Image size 2212x1659. Color fundus image:
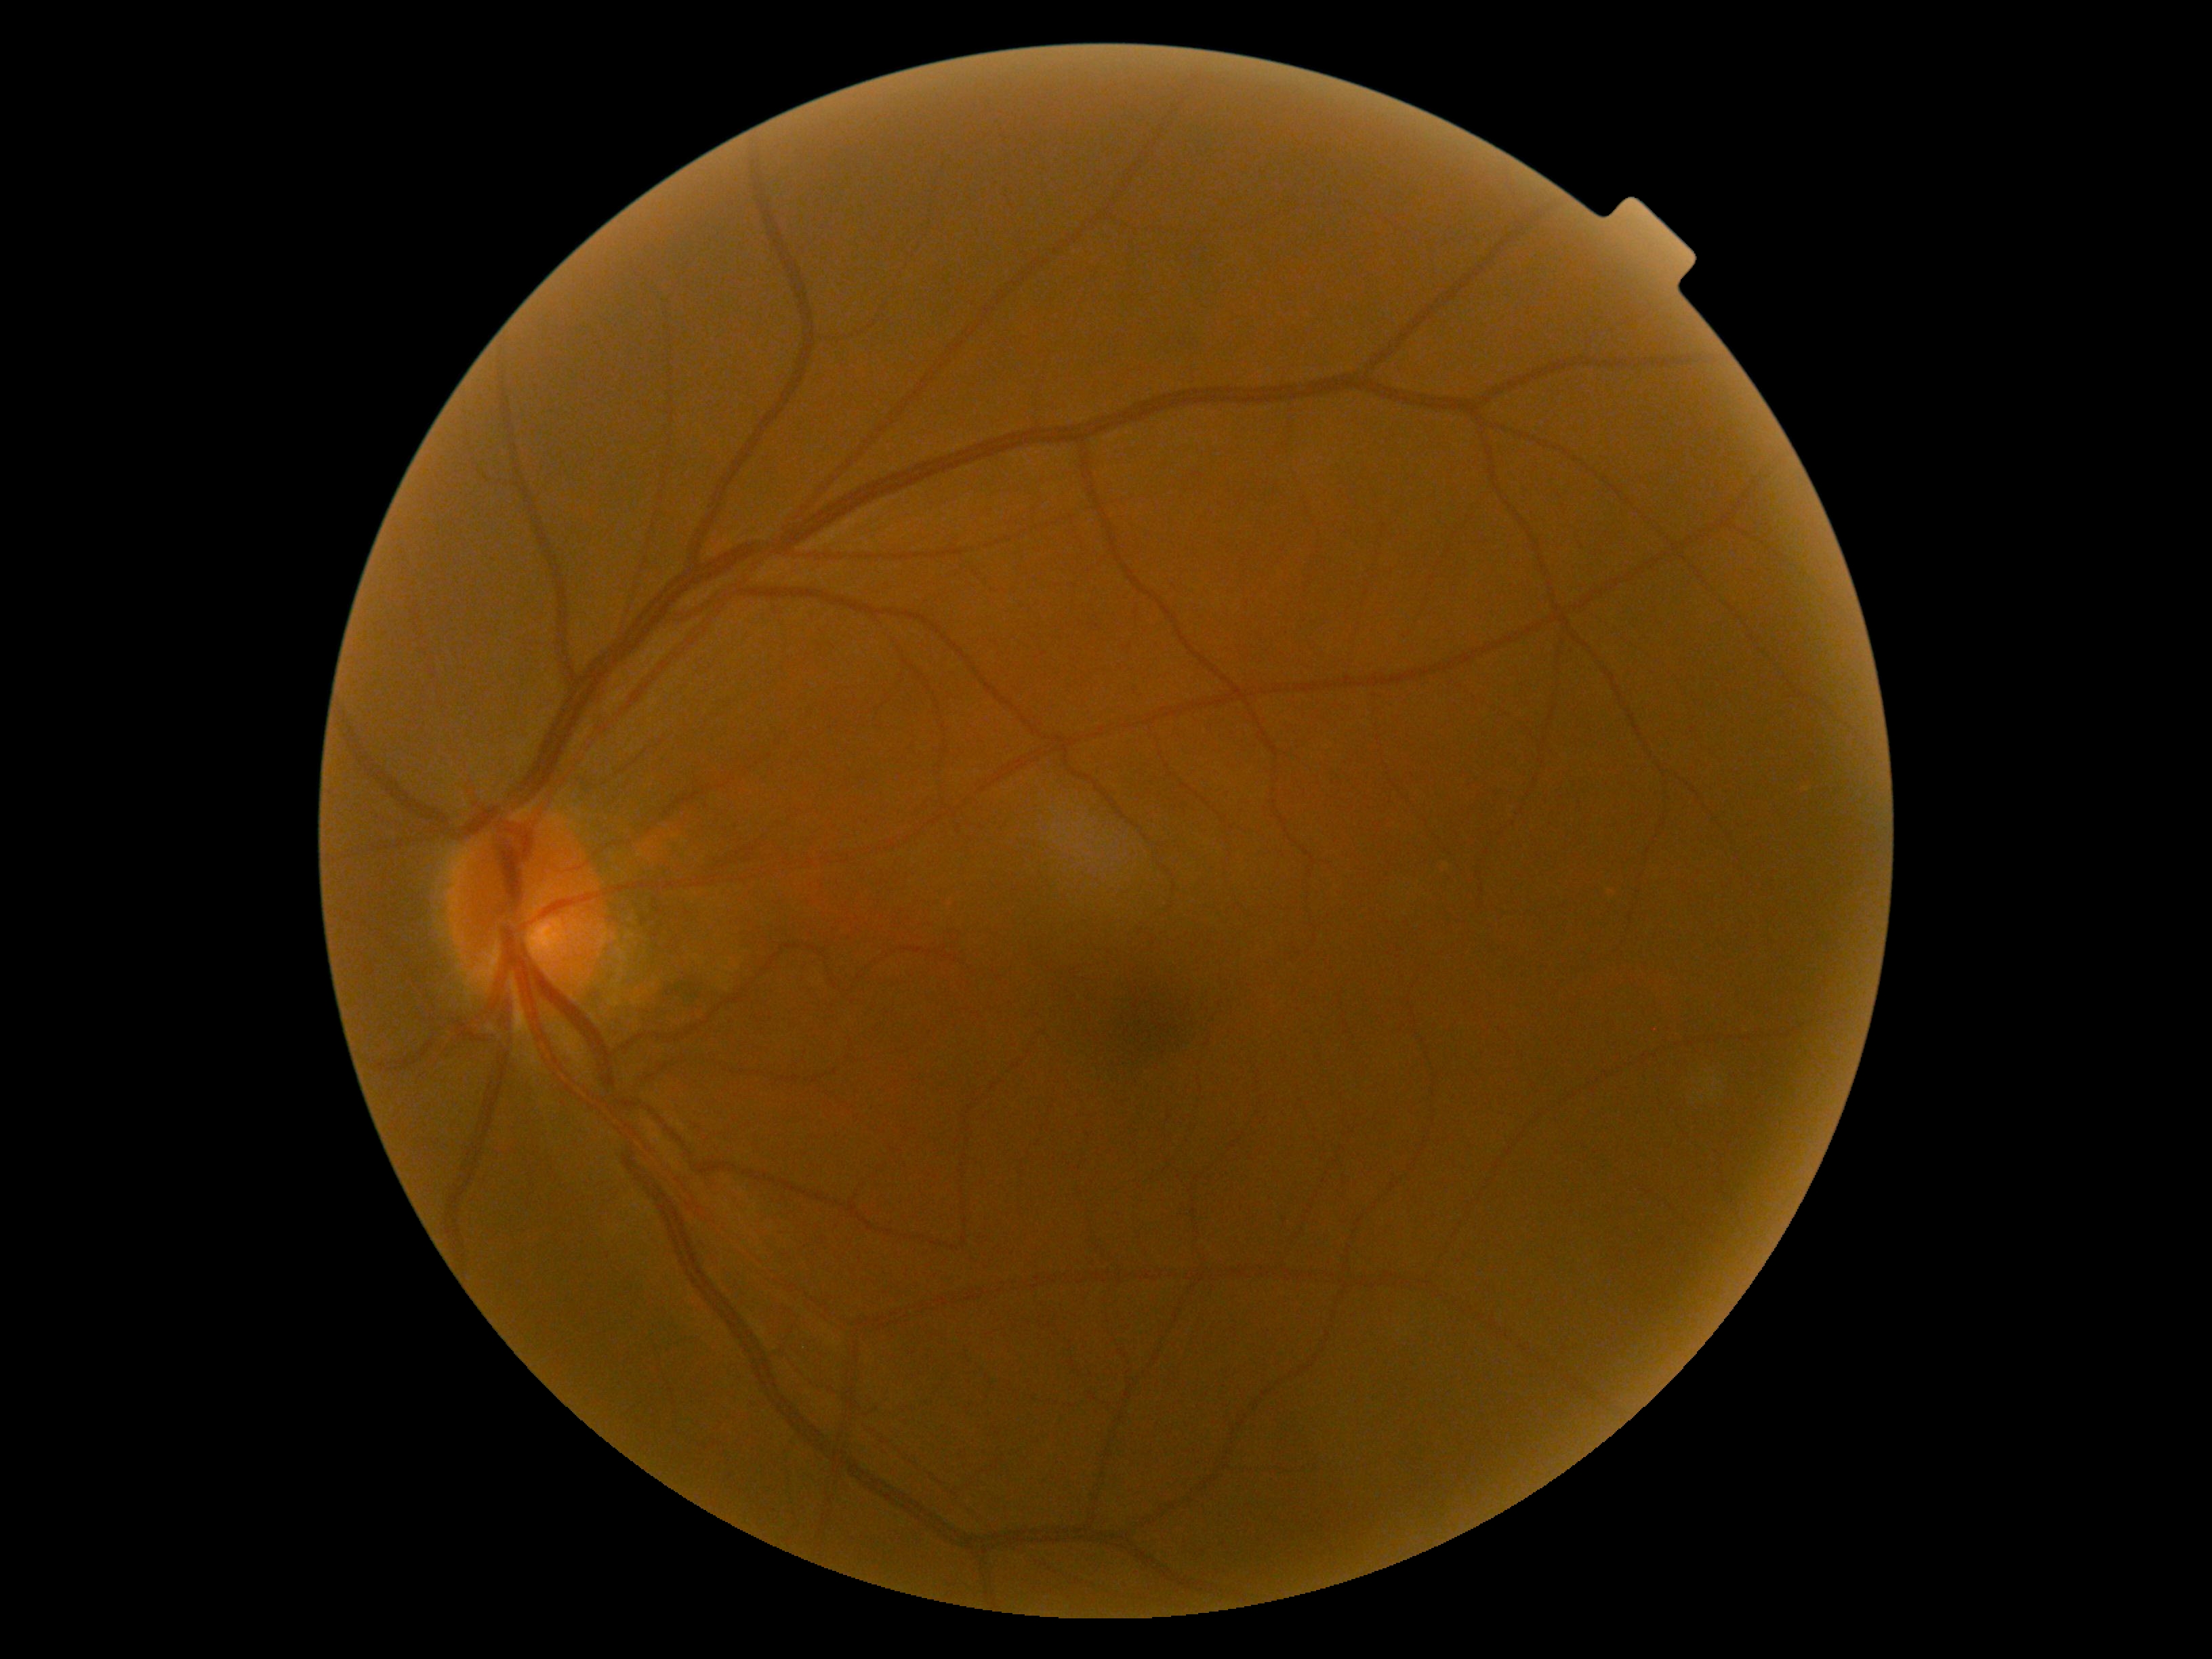
Retinopathy grade: 0.